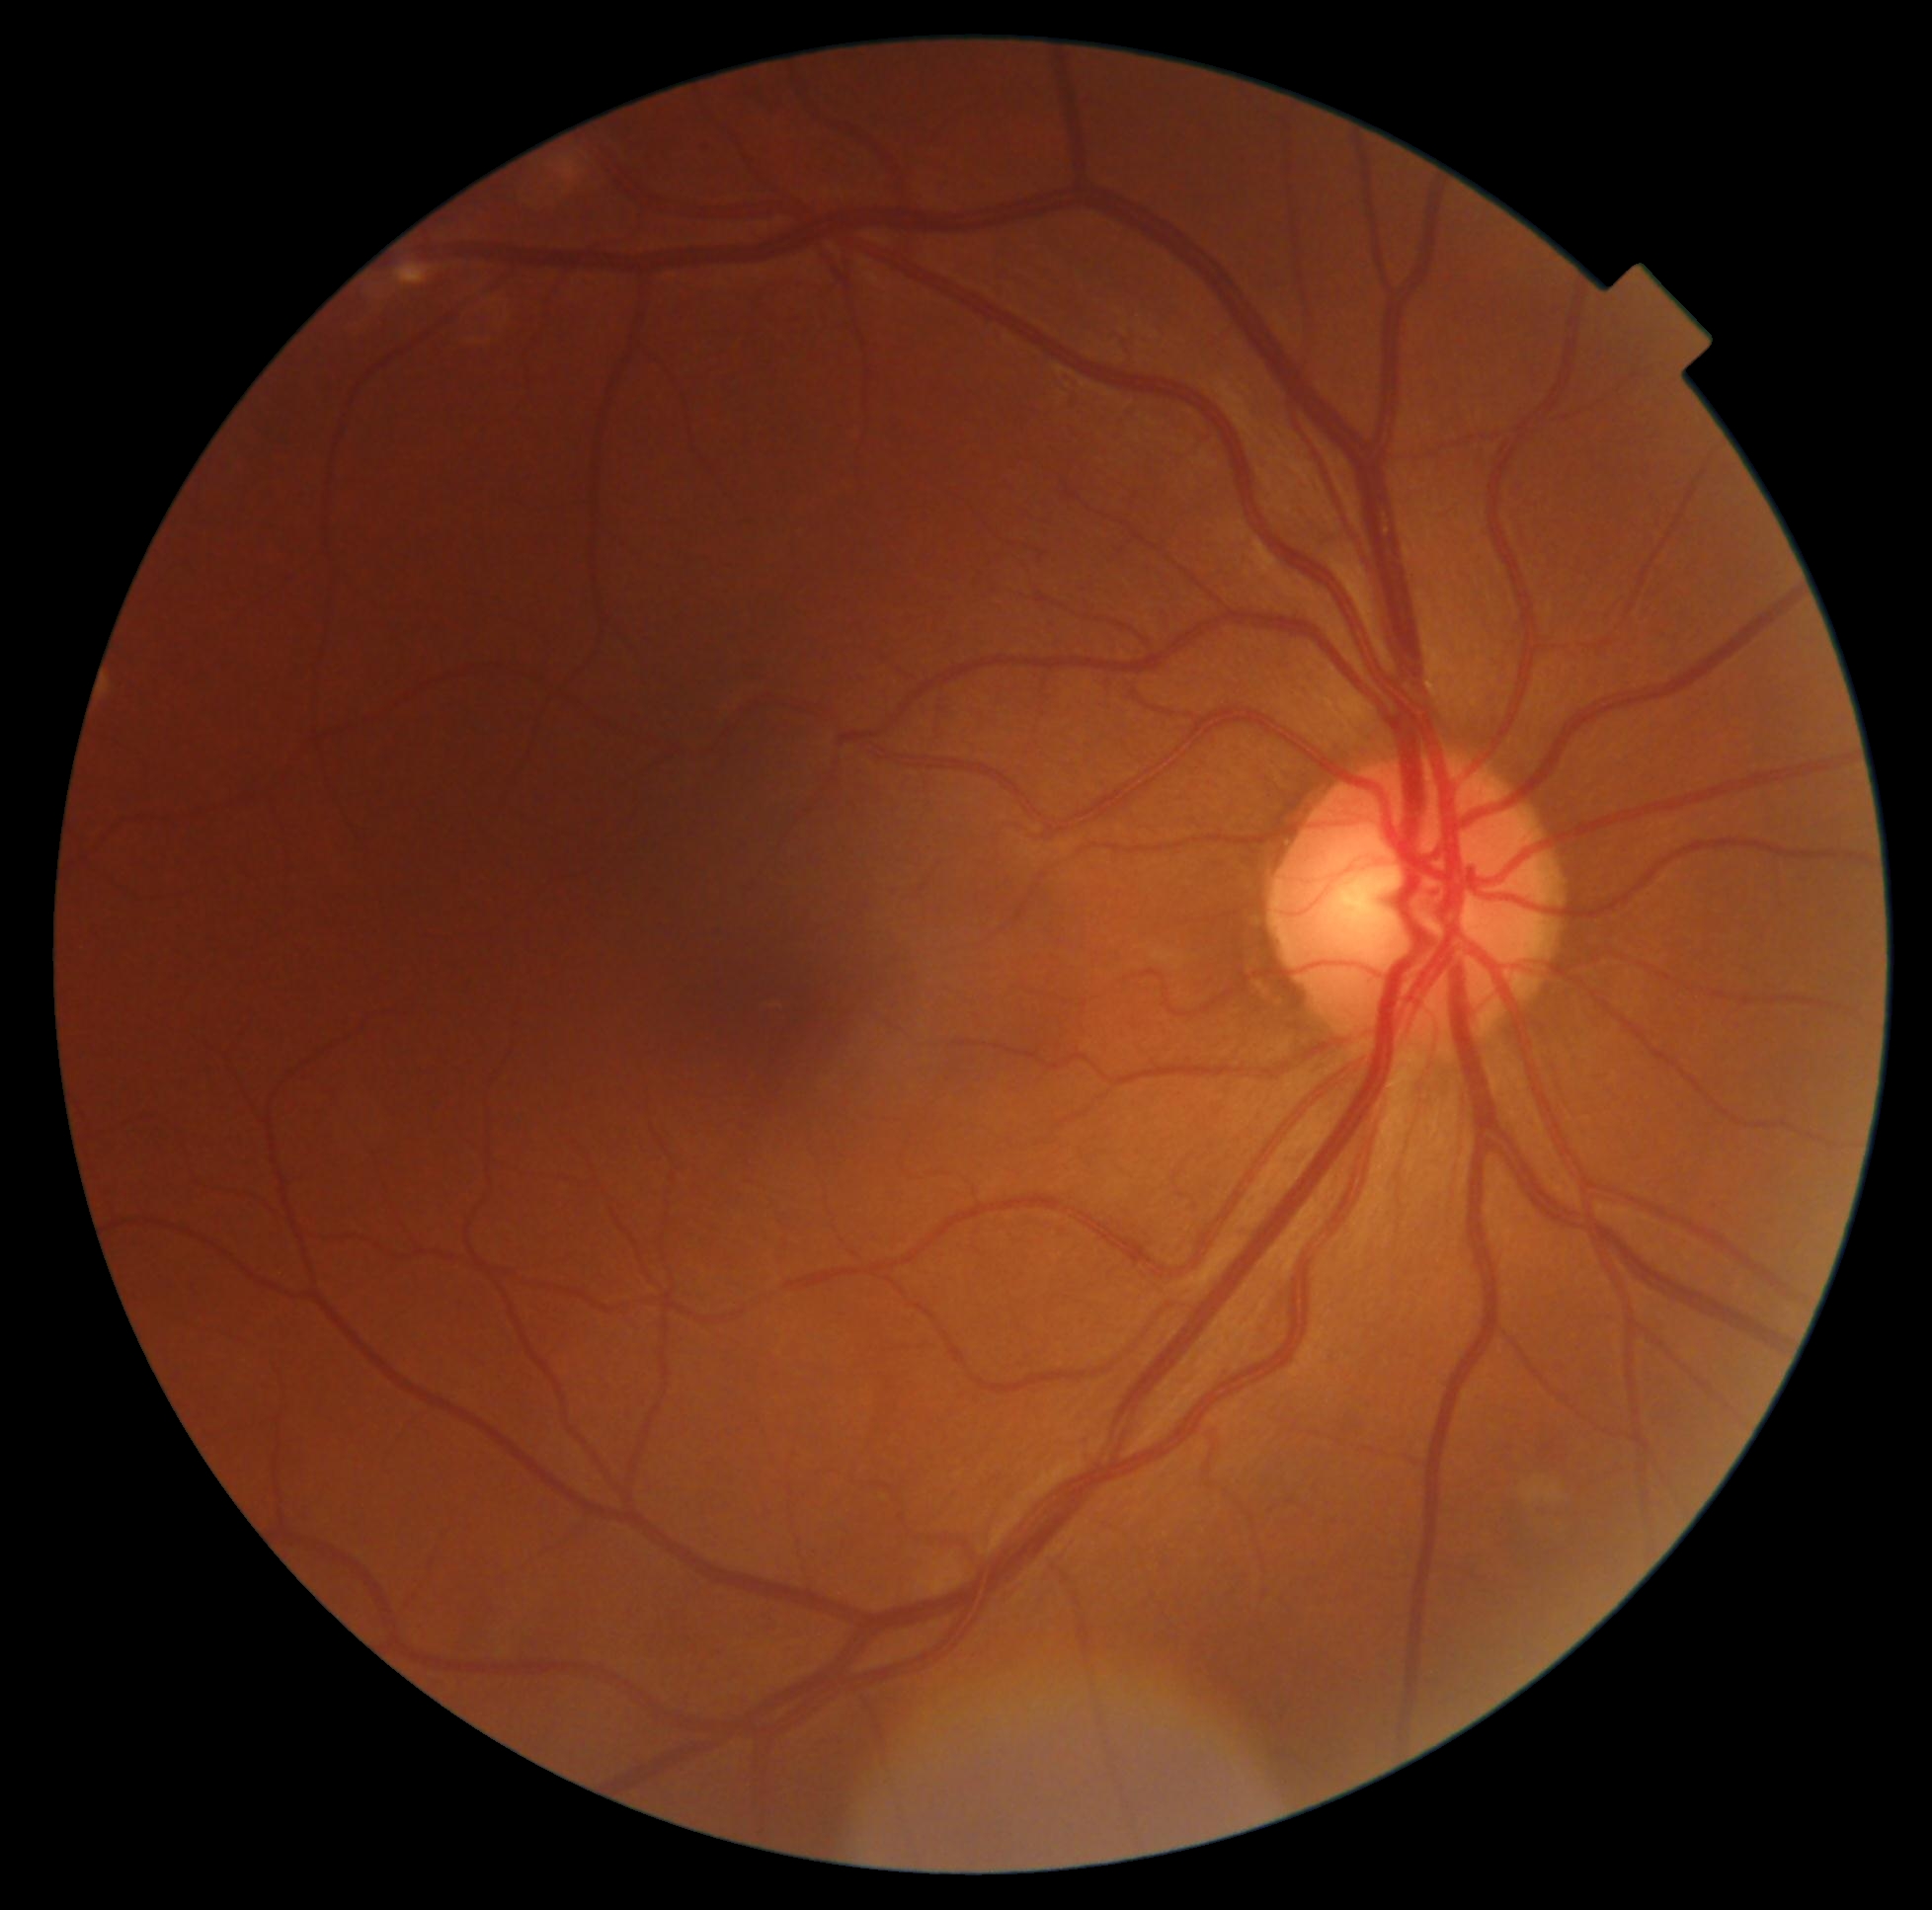

No signs of diabetic retinopathy.
DR stage: grade 0 (no apparent retinopathy).